Fundus photo
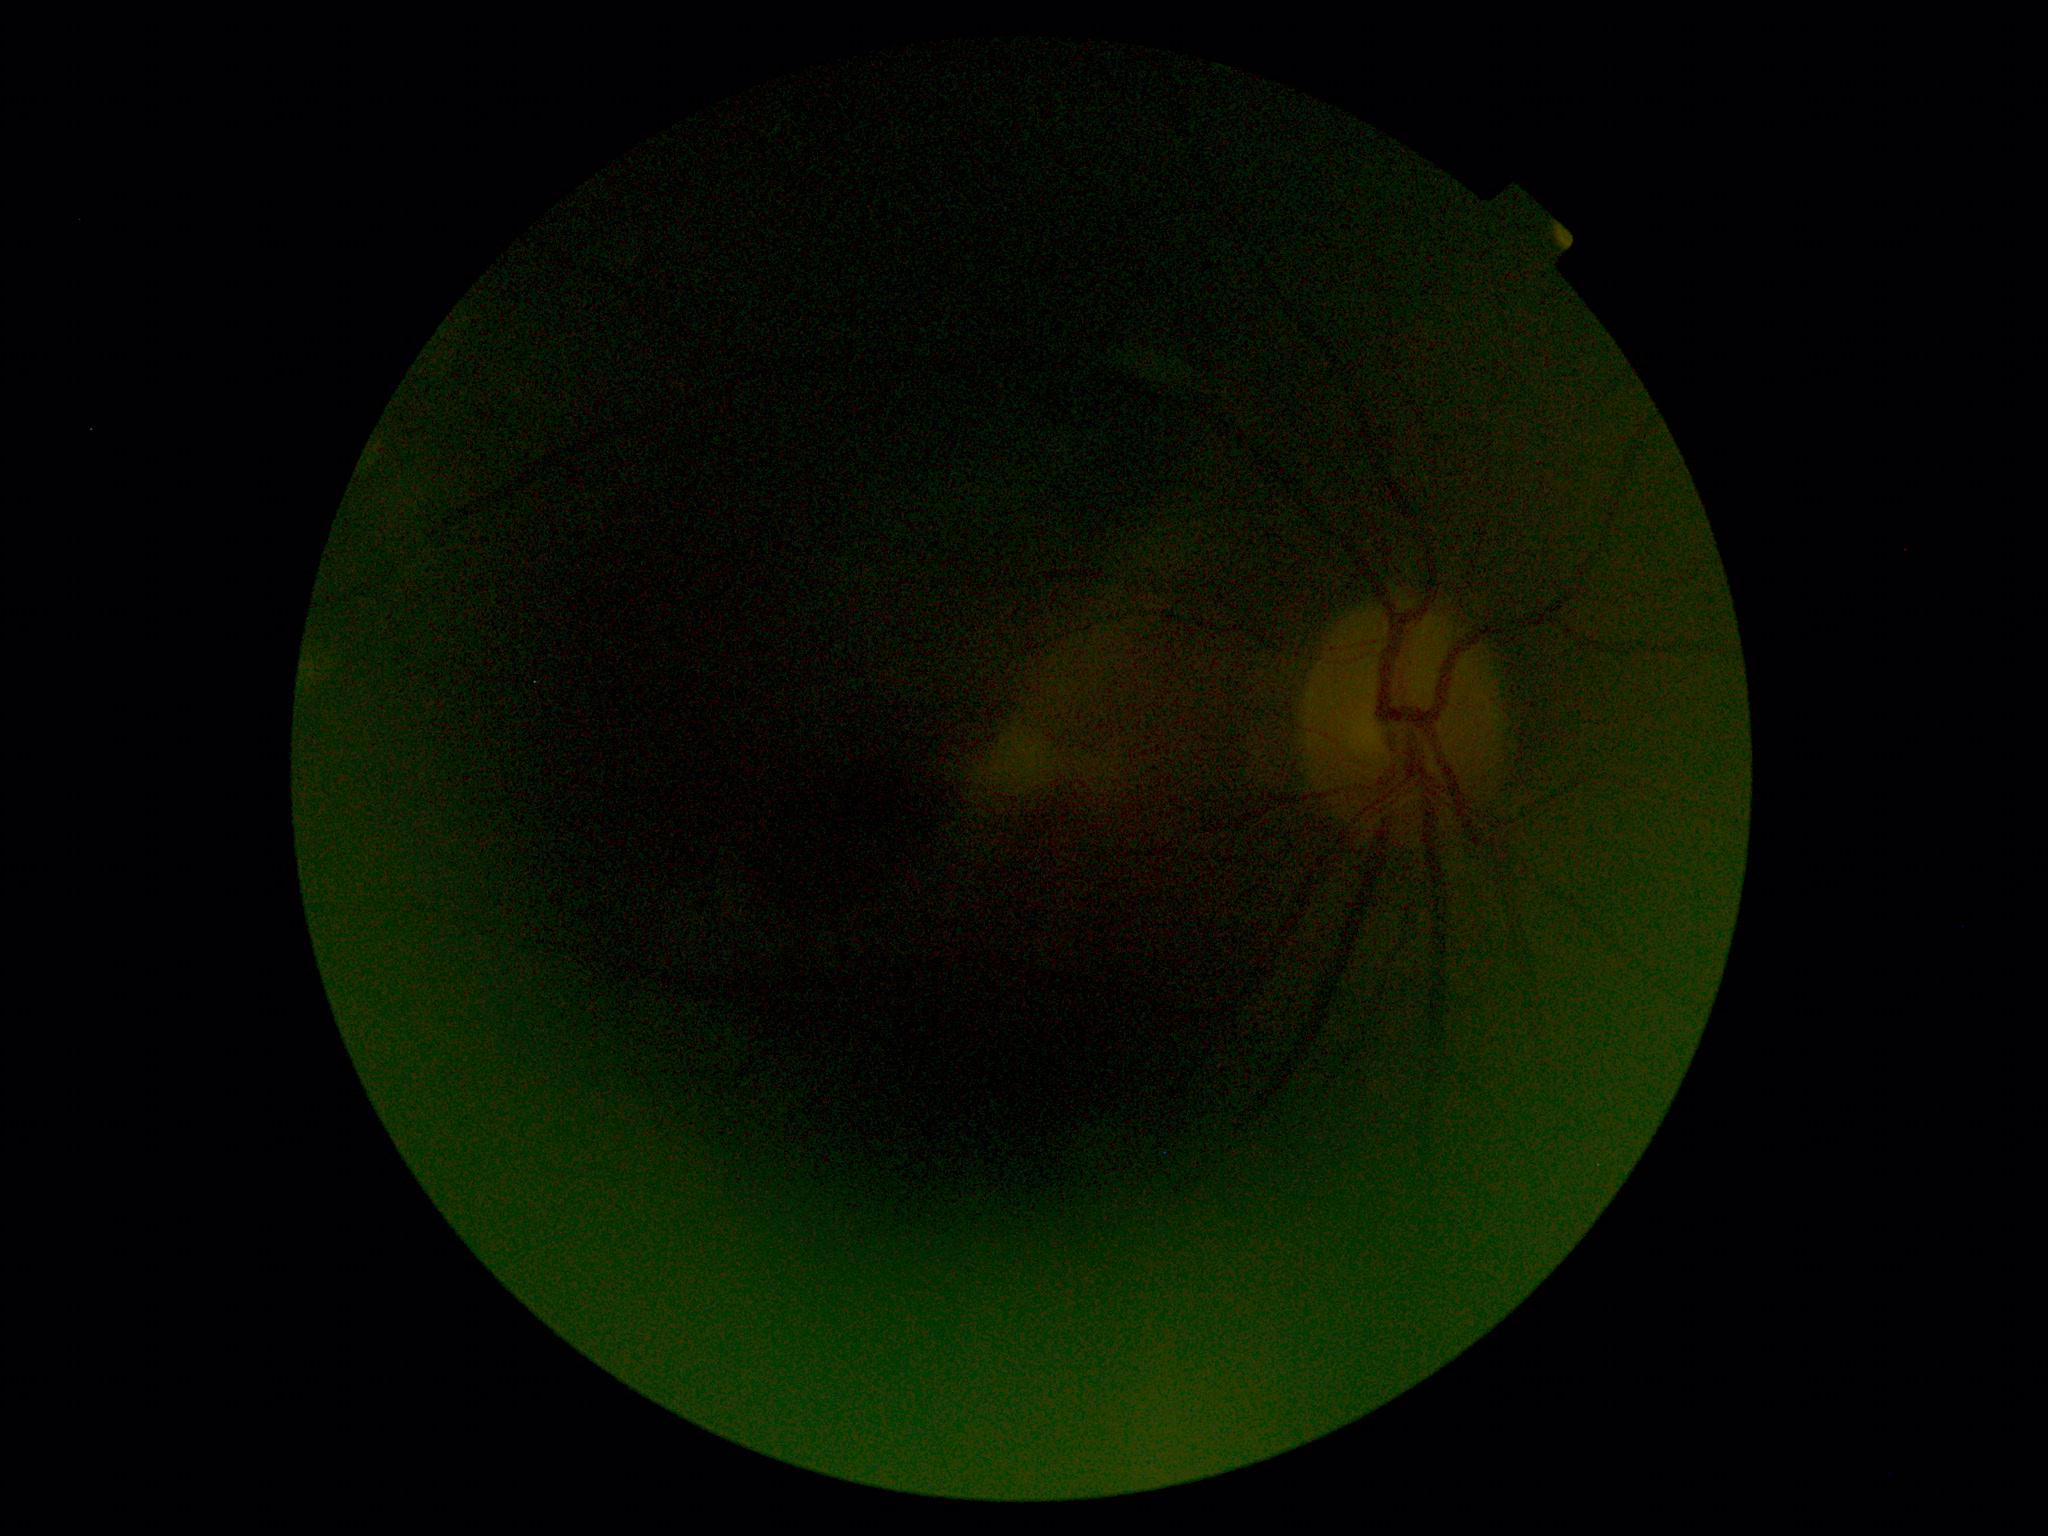
DR stage is ungradable.